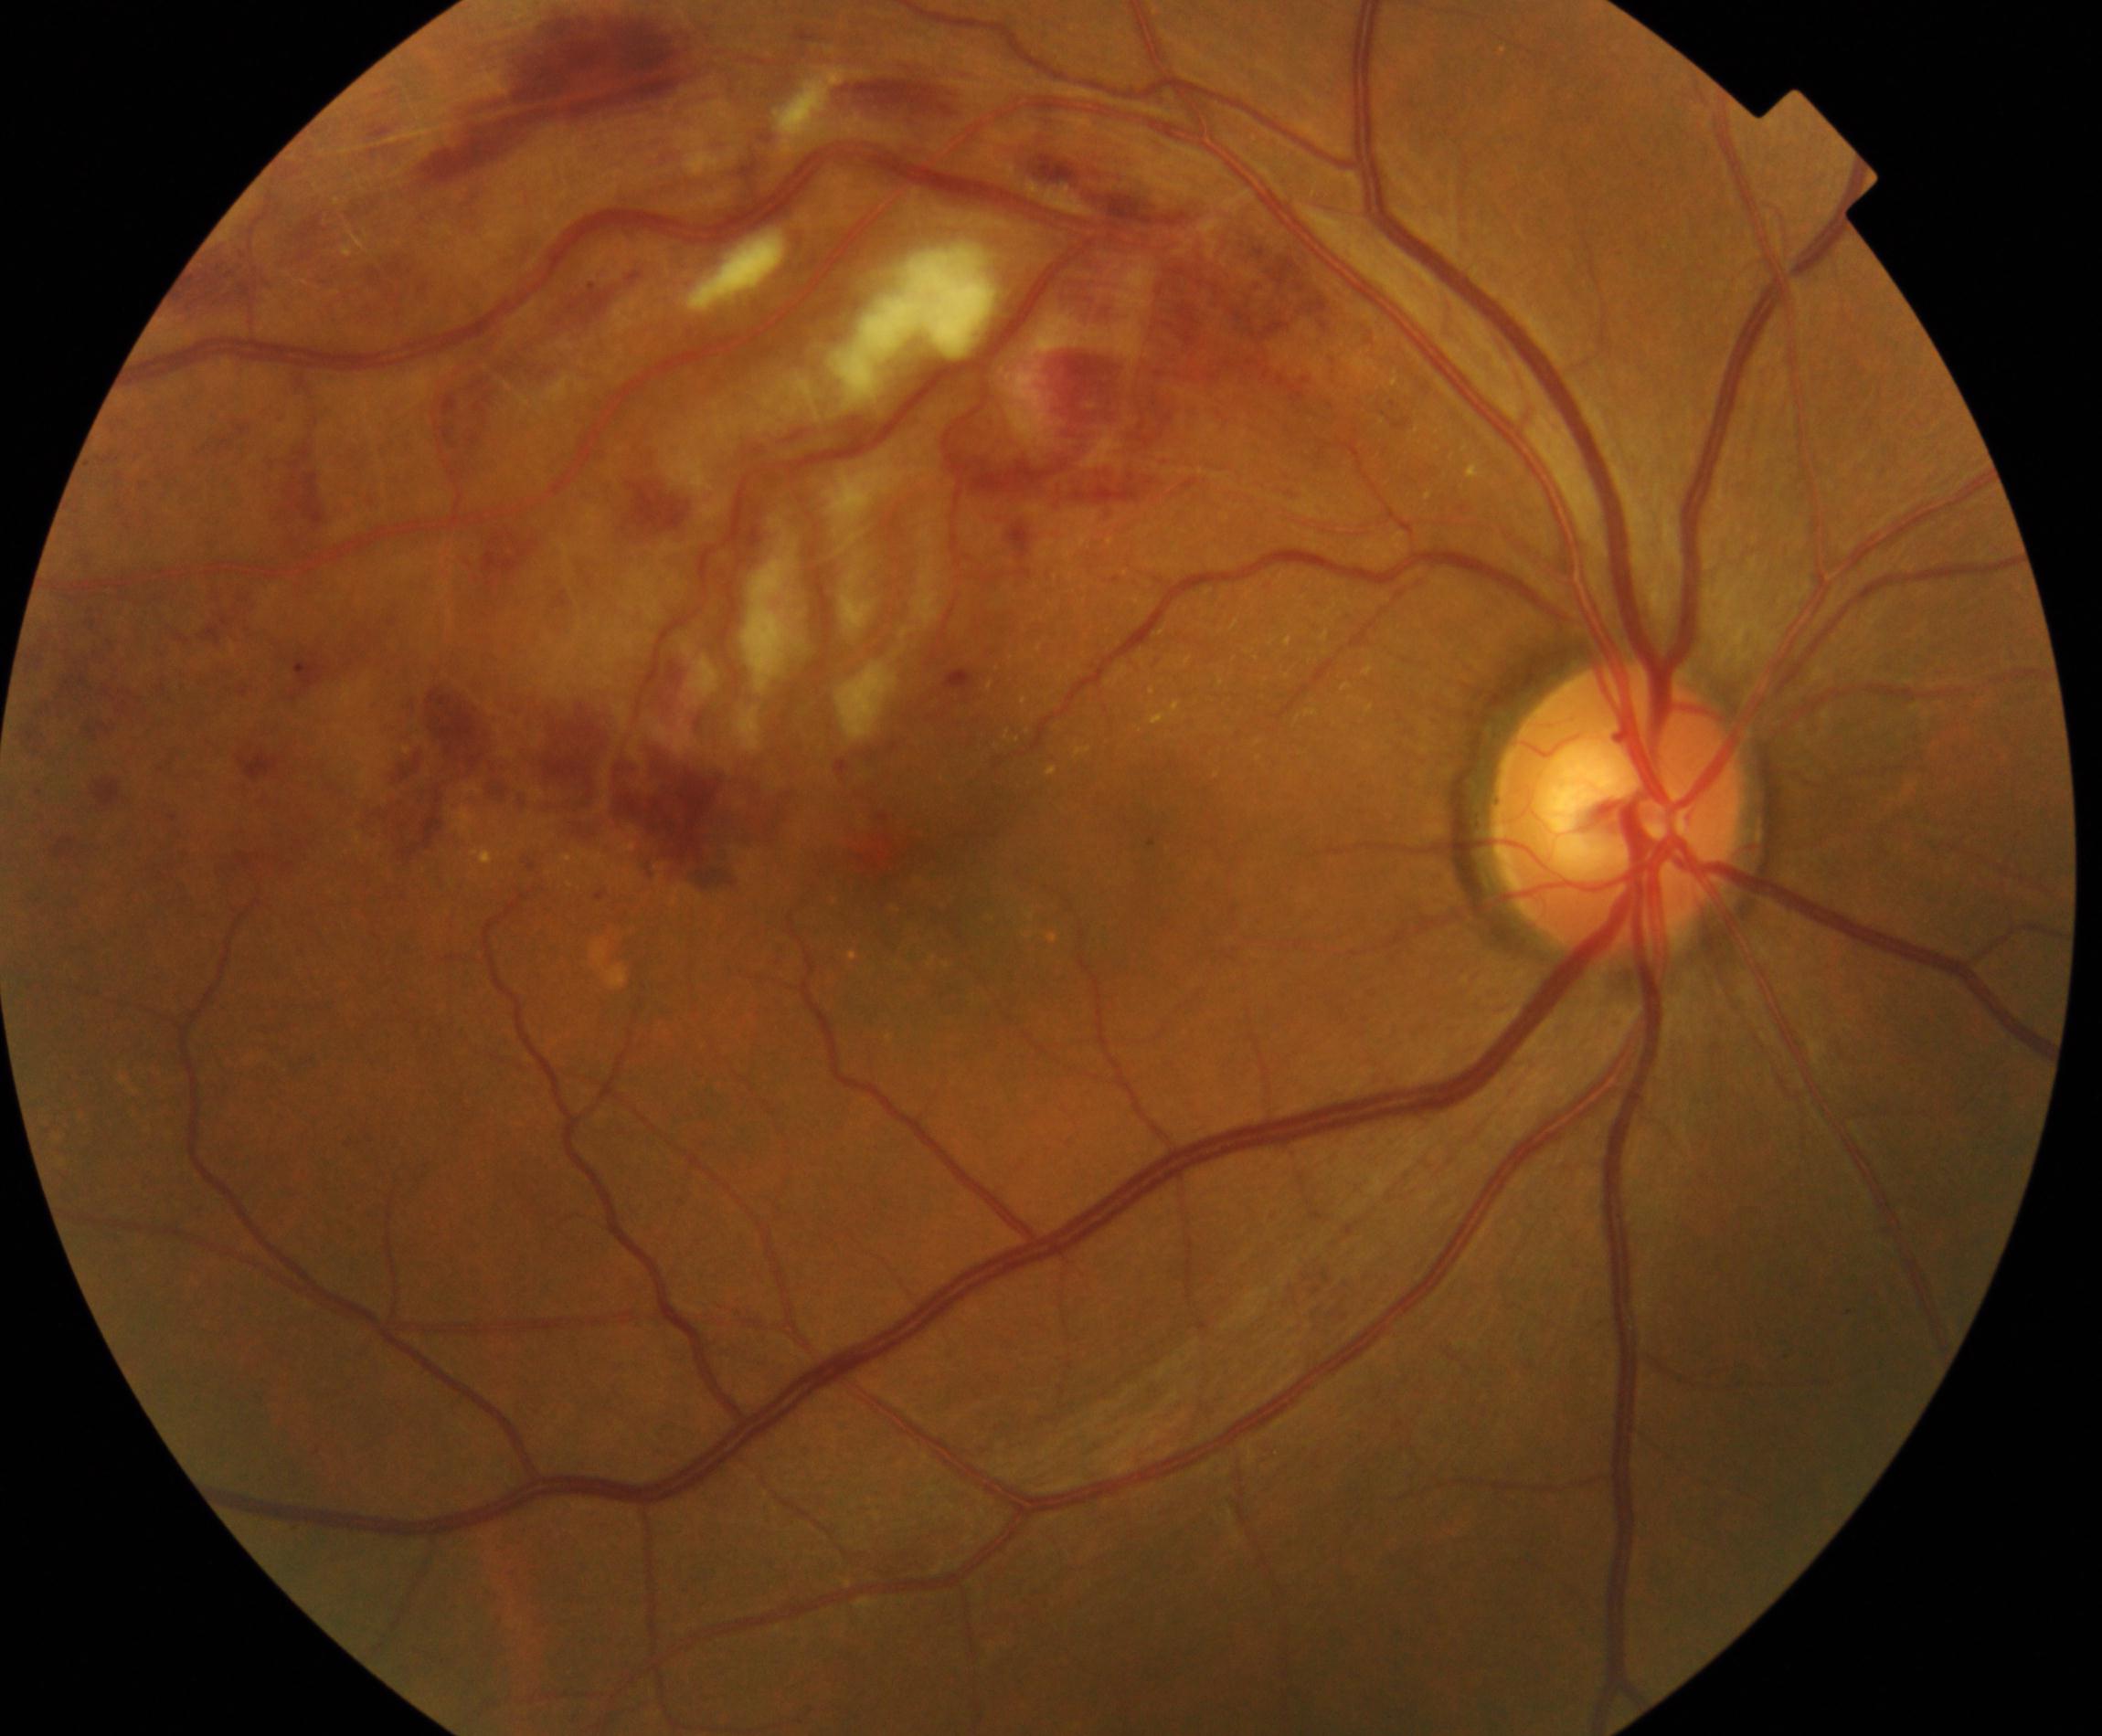

Fundus image consistent with branch retinal vein occlusion.